CFP, 1659 x 2212 pixels: 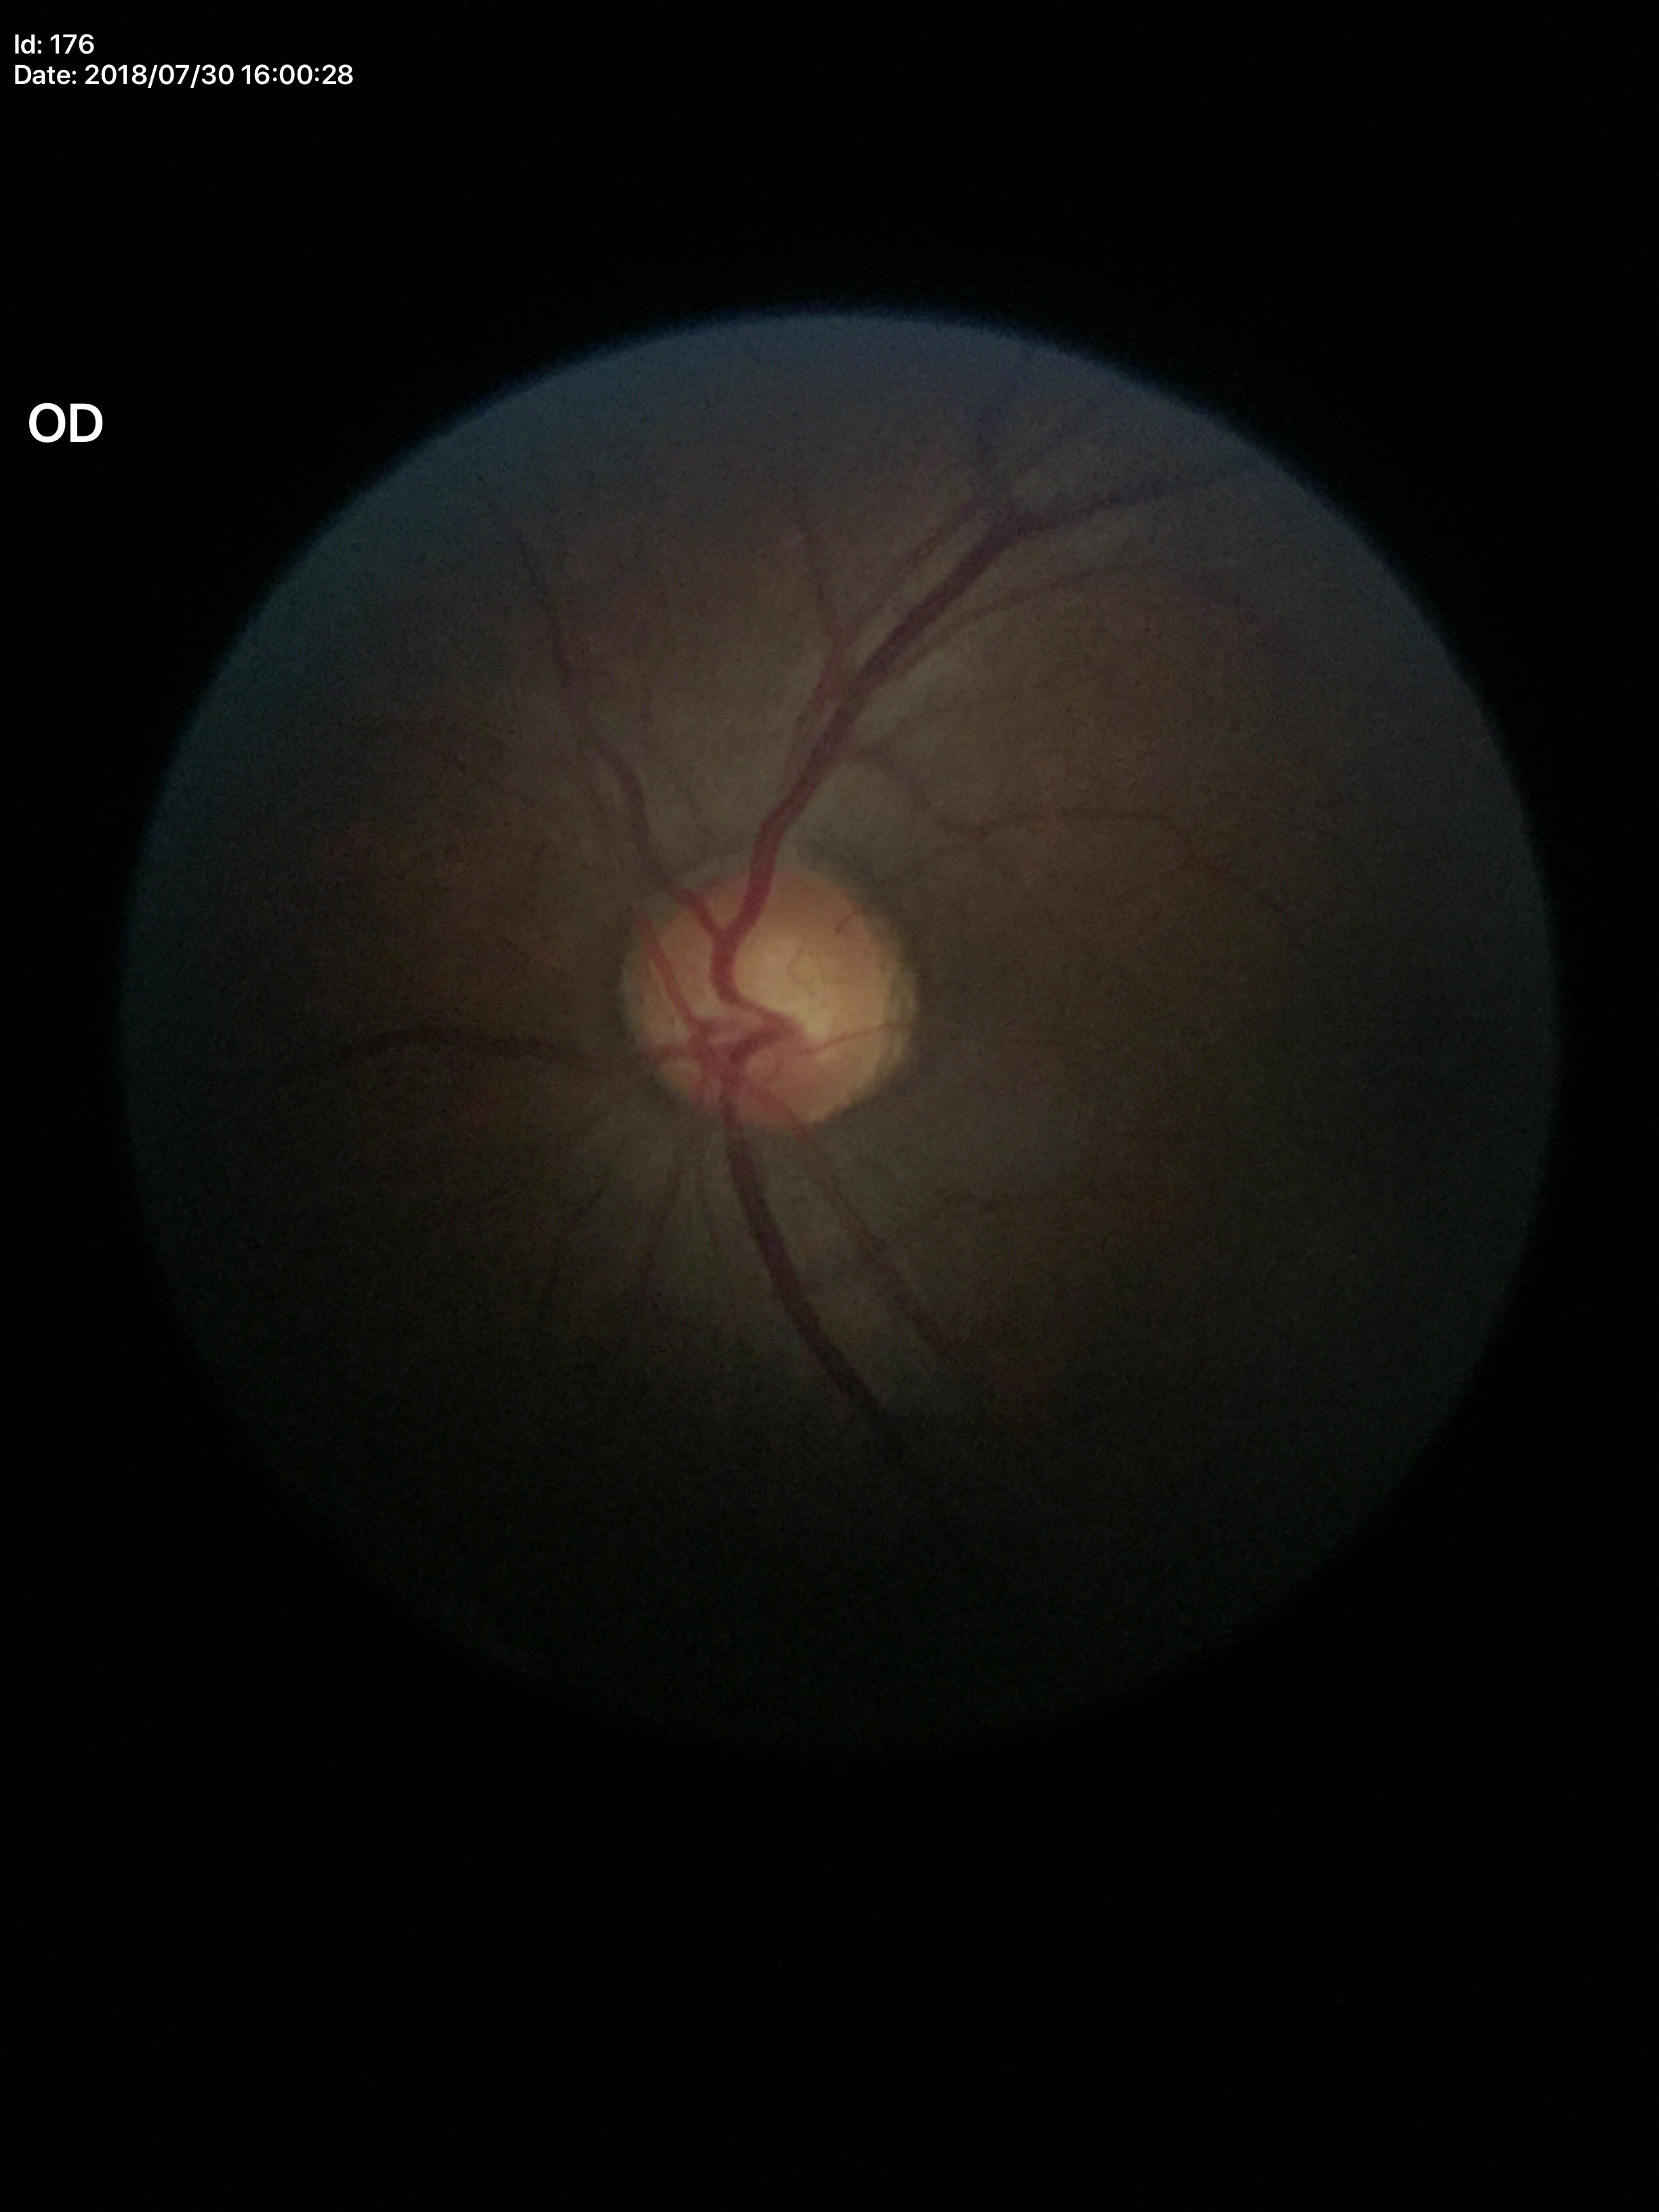 Glaucoma screening = not suspect; vertical cup-to-disc ratio = 0.59.